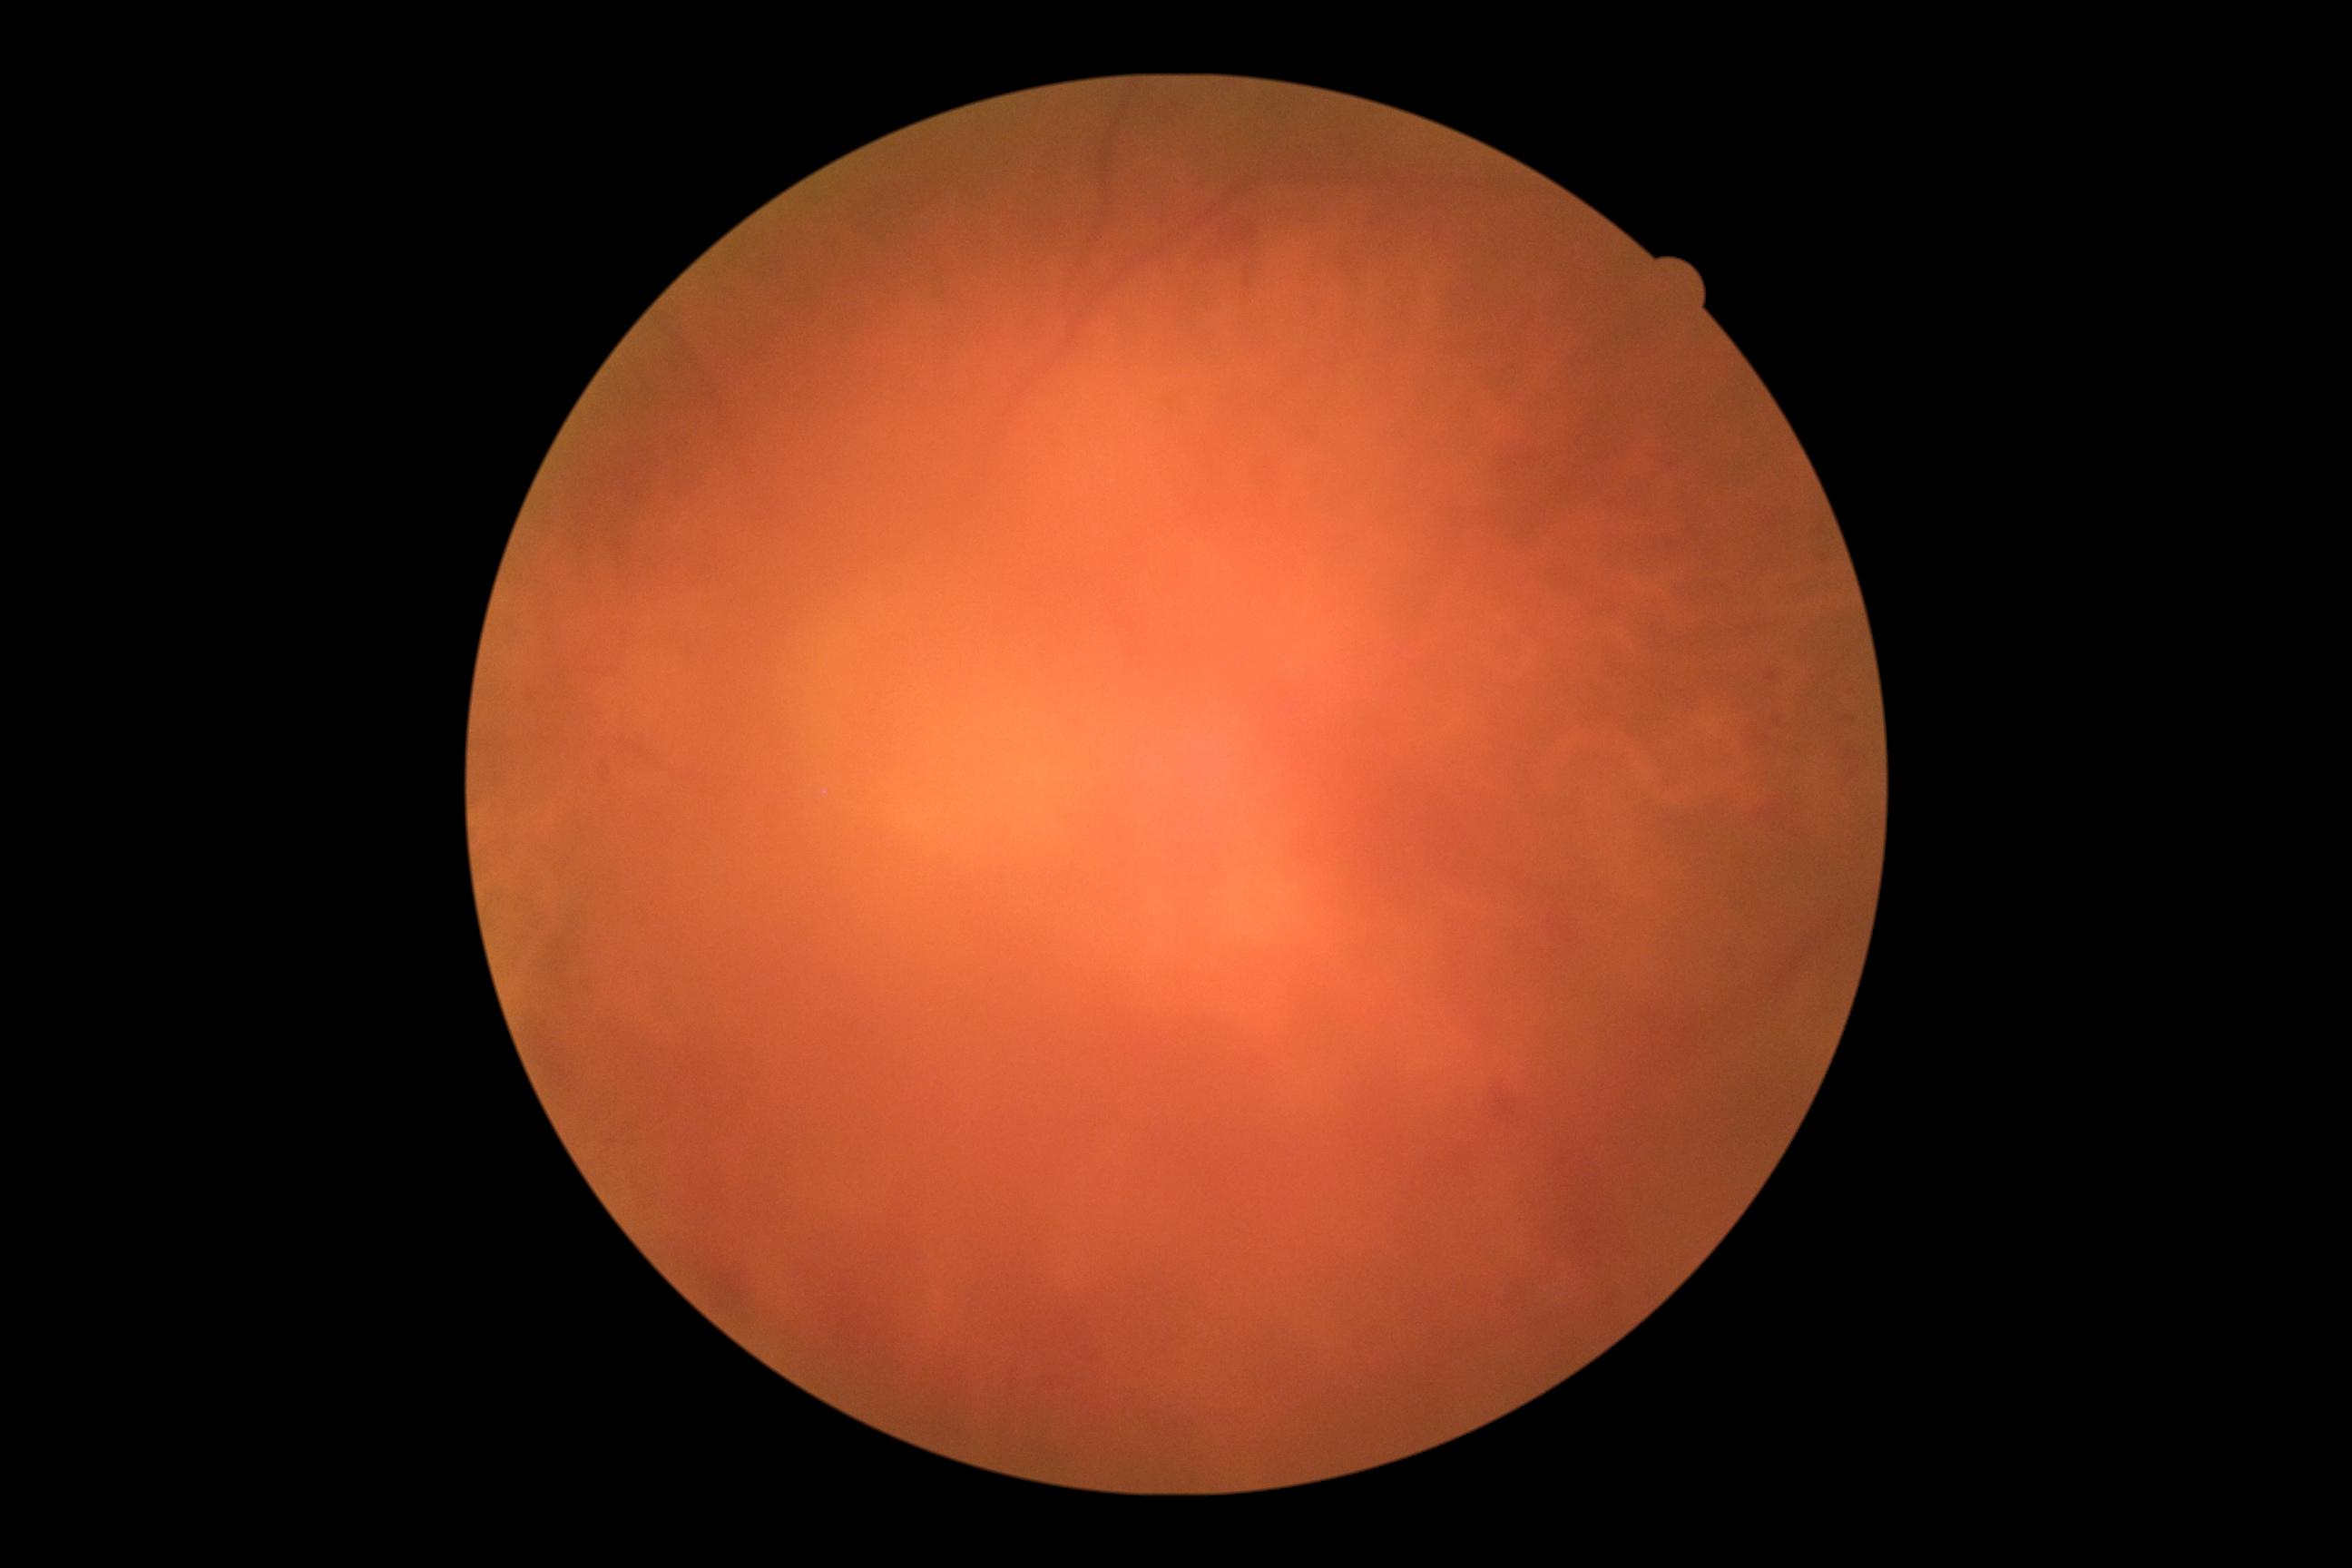

image quality=insufficient for DR assessment; DR severity=ungradable.